Modified Davis grading:
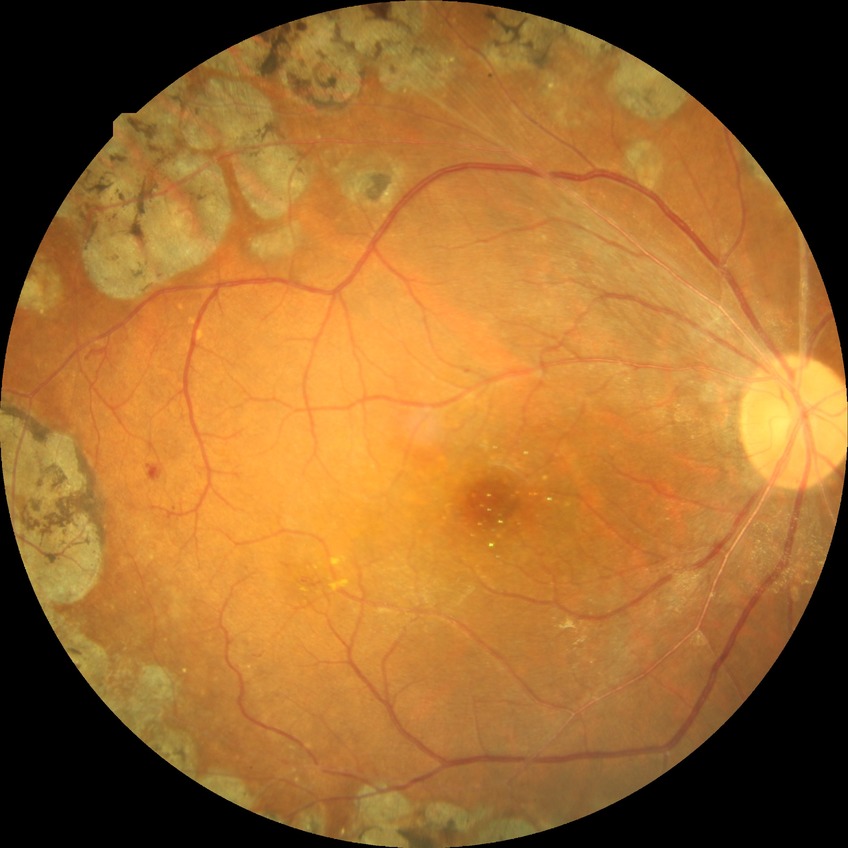 Davis grading is proliferative diabetic retinopathy.